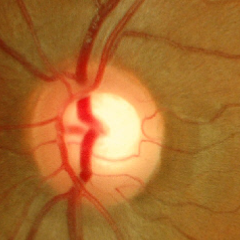 No glaucomatous changes.